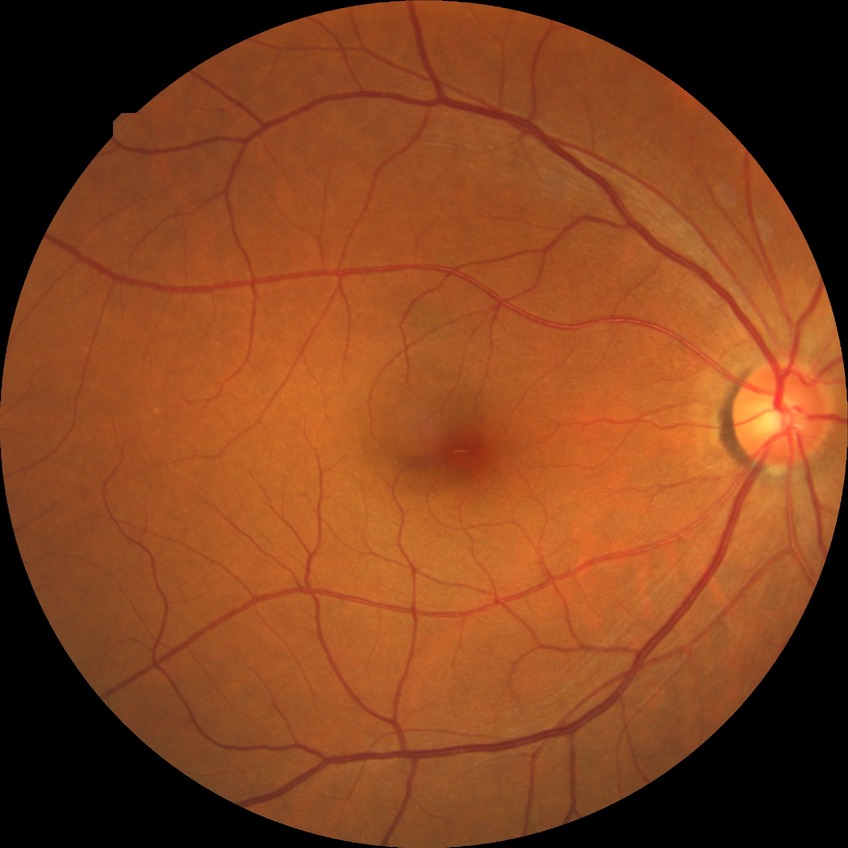
Findings:
• diabetic retinopathy (DR): NDR (no diabetic retinopathy)